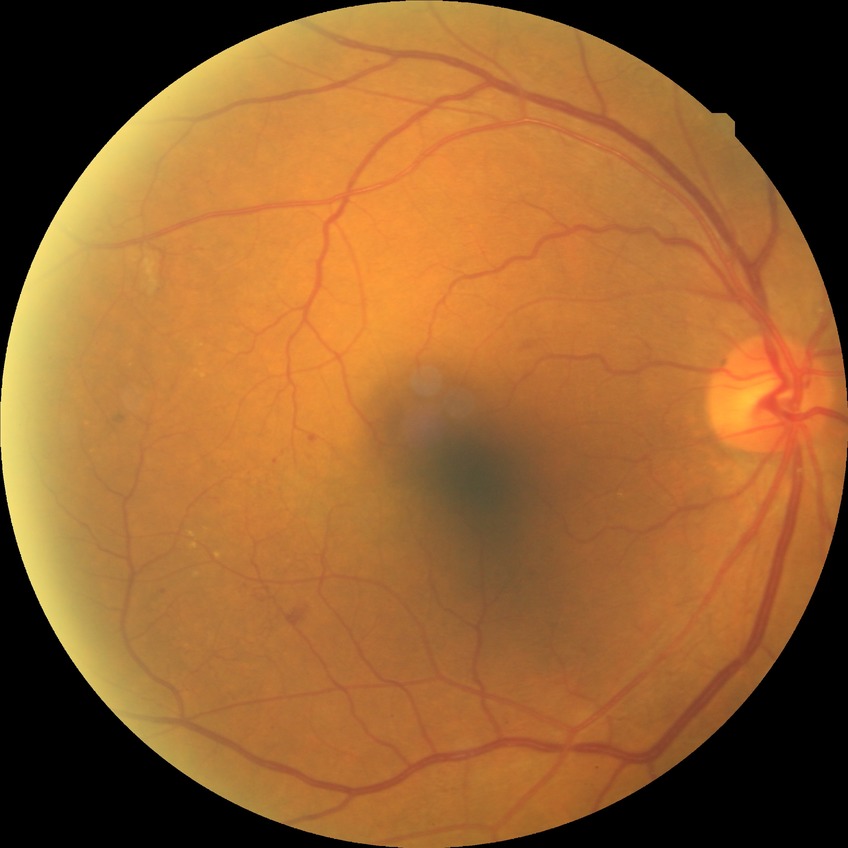

Diabetic retinopathy (DR): pre-proliferative diabetic retinopathy (PPDR).
DR class: non-proliferative diabetic retinopathy.